Retinal fundus photograph:
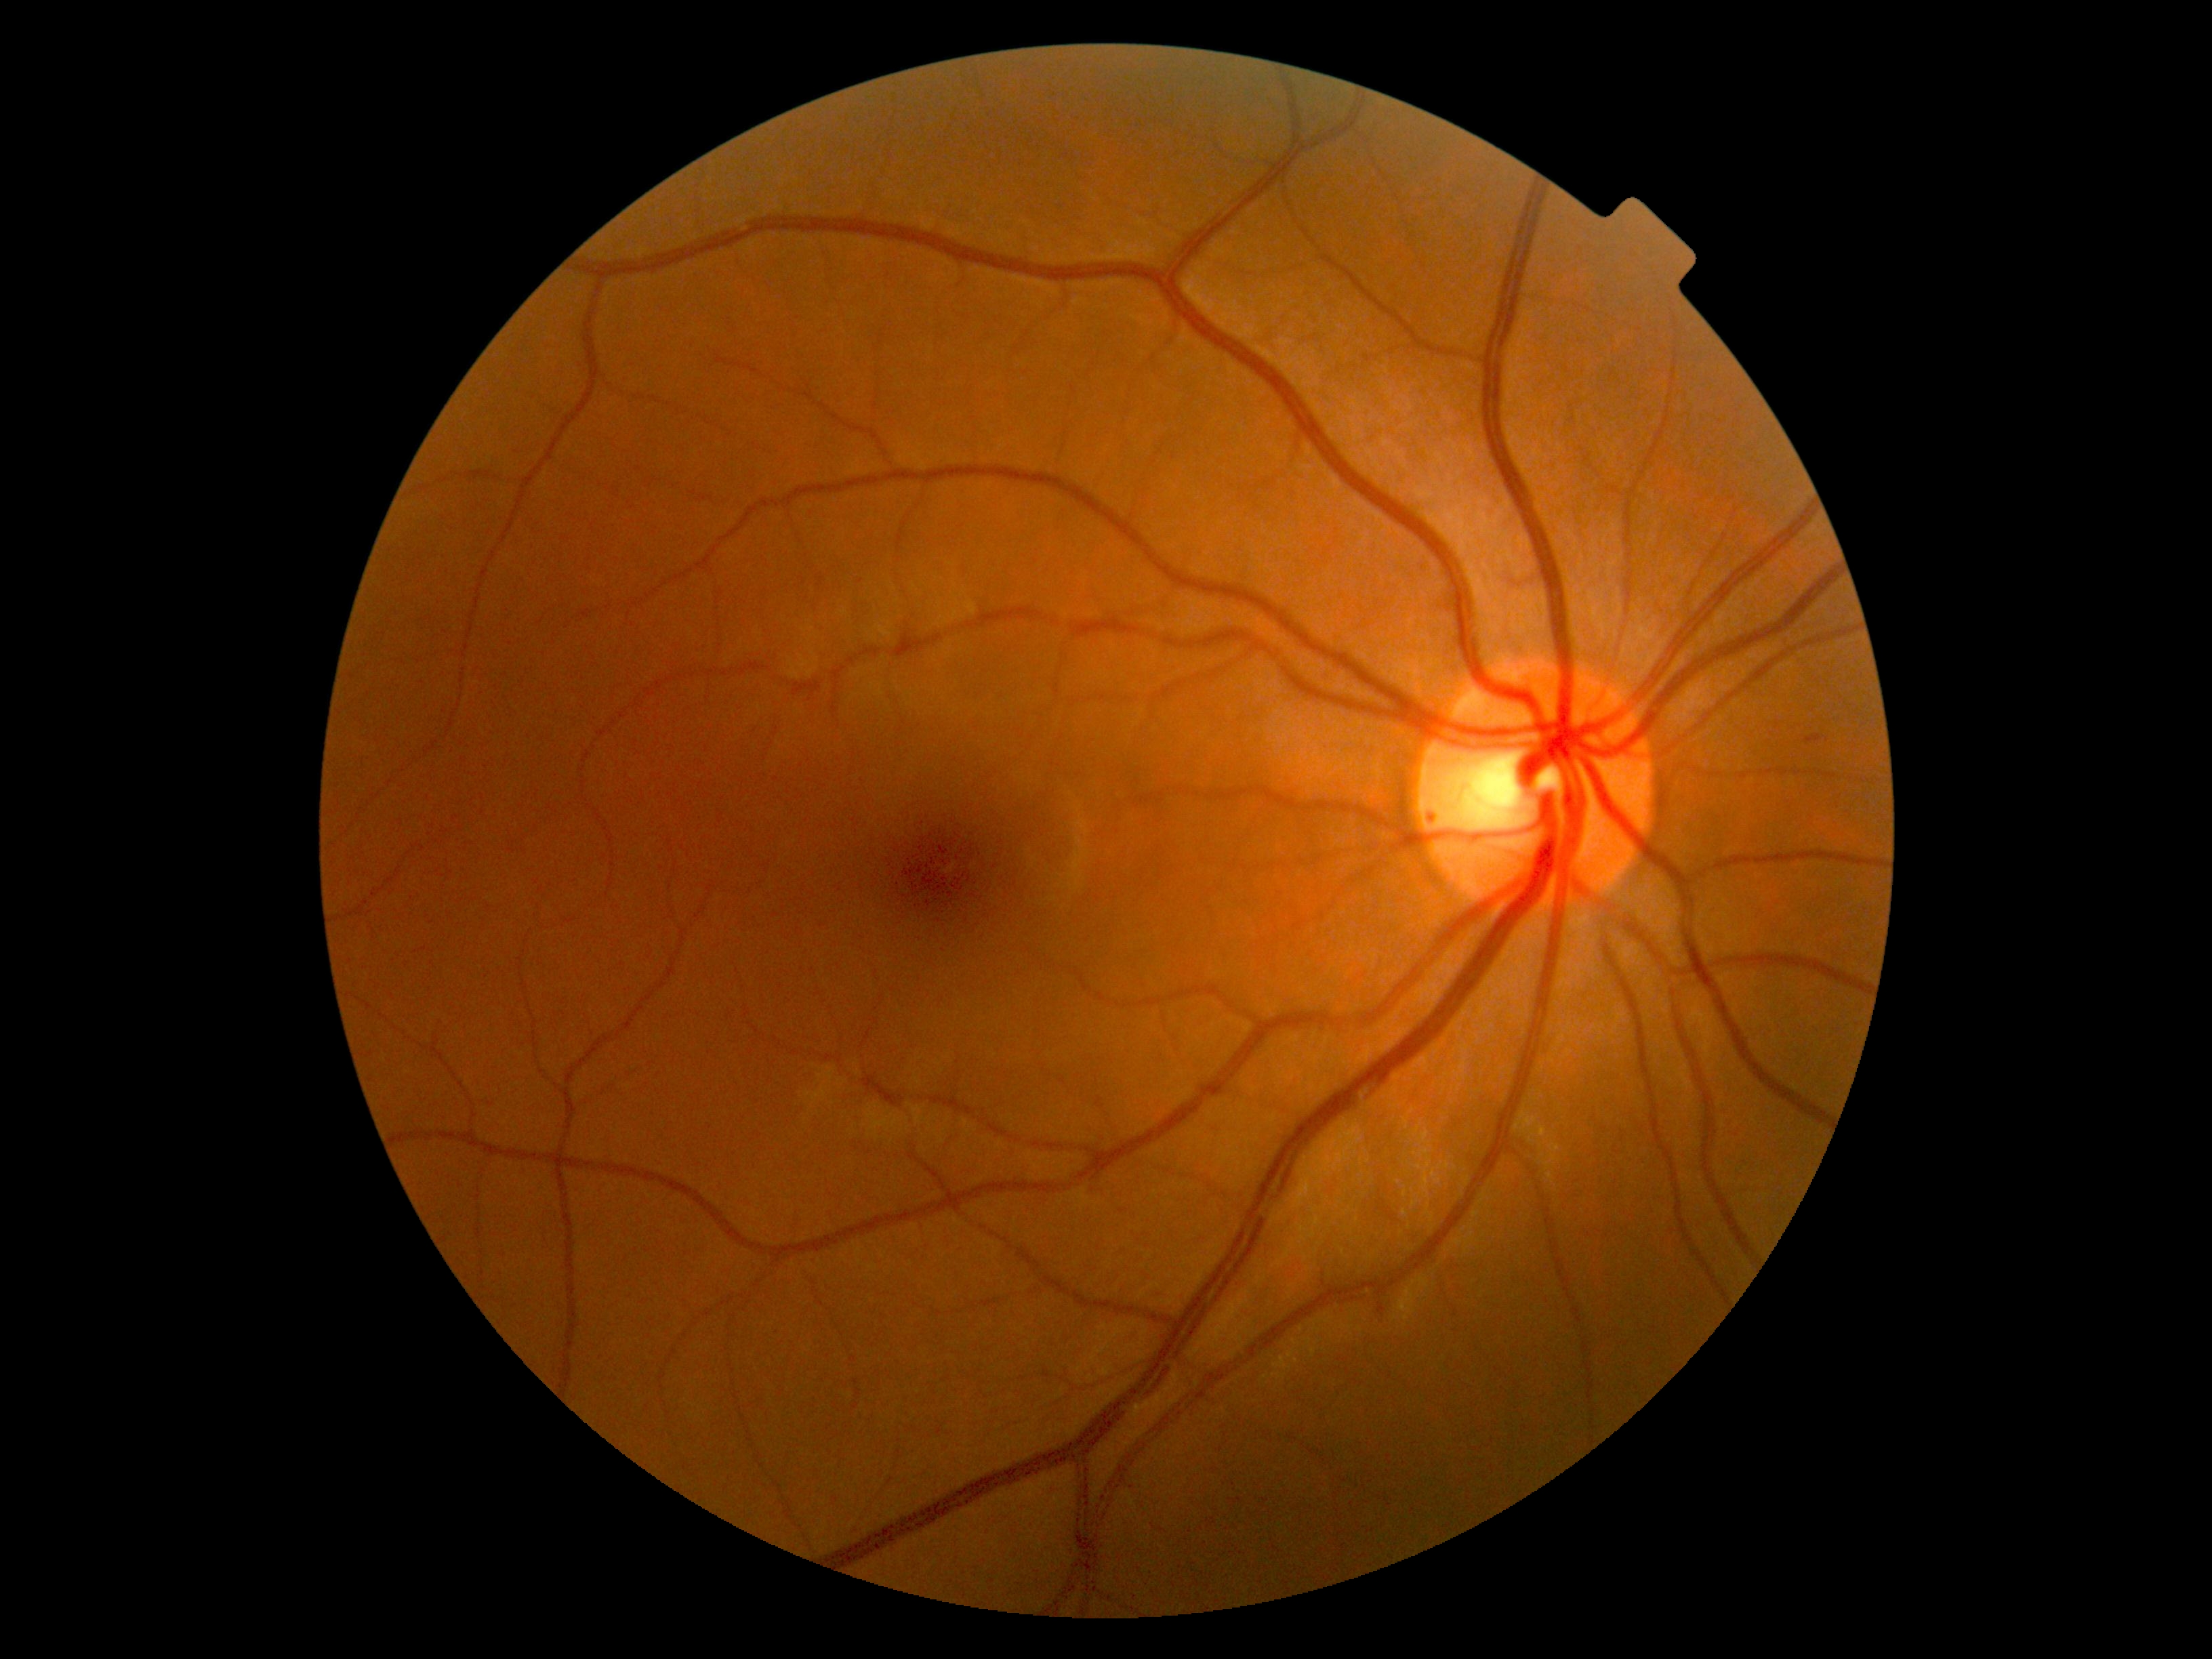
DR severity: grade 2 (moderate NPDR).